CFP; acquired with a Remidio smartphone fundus camera:
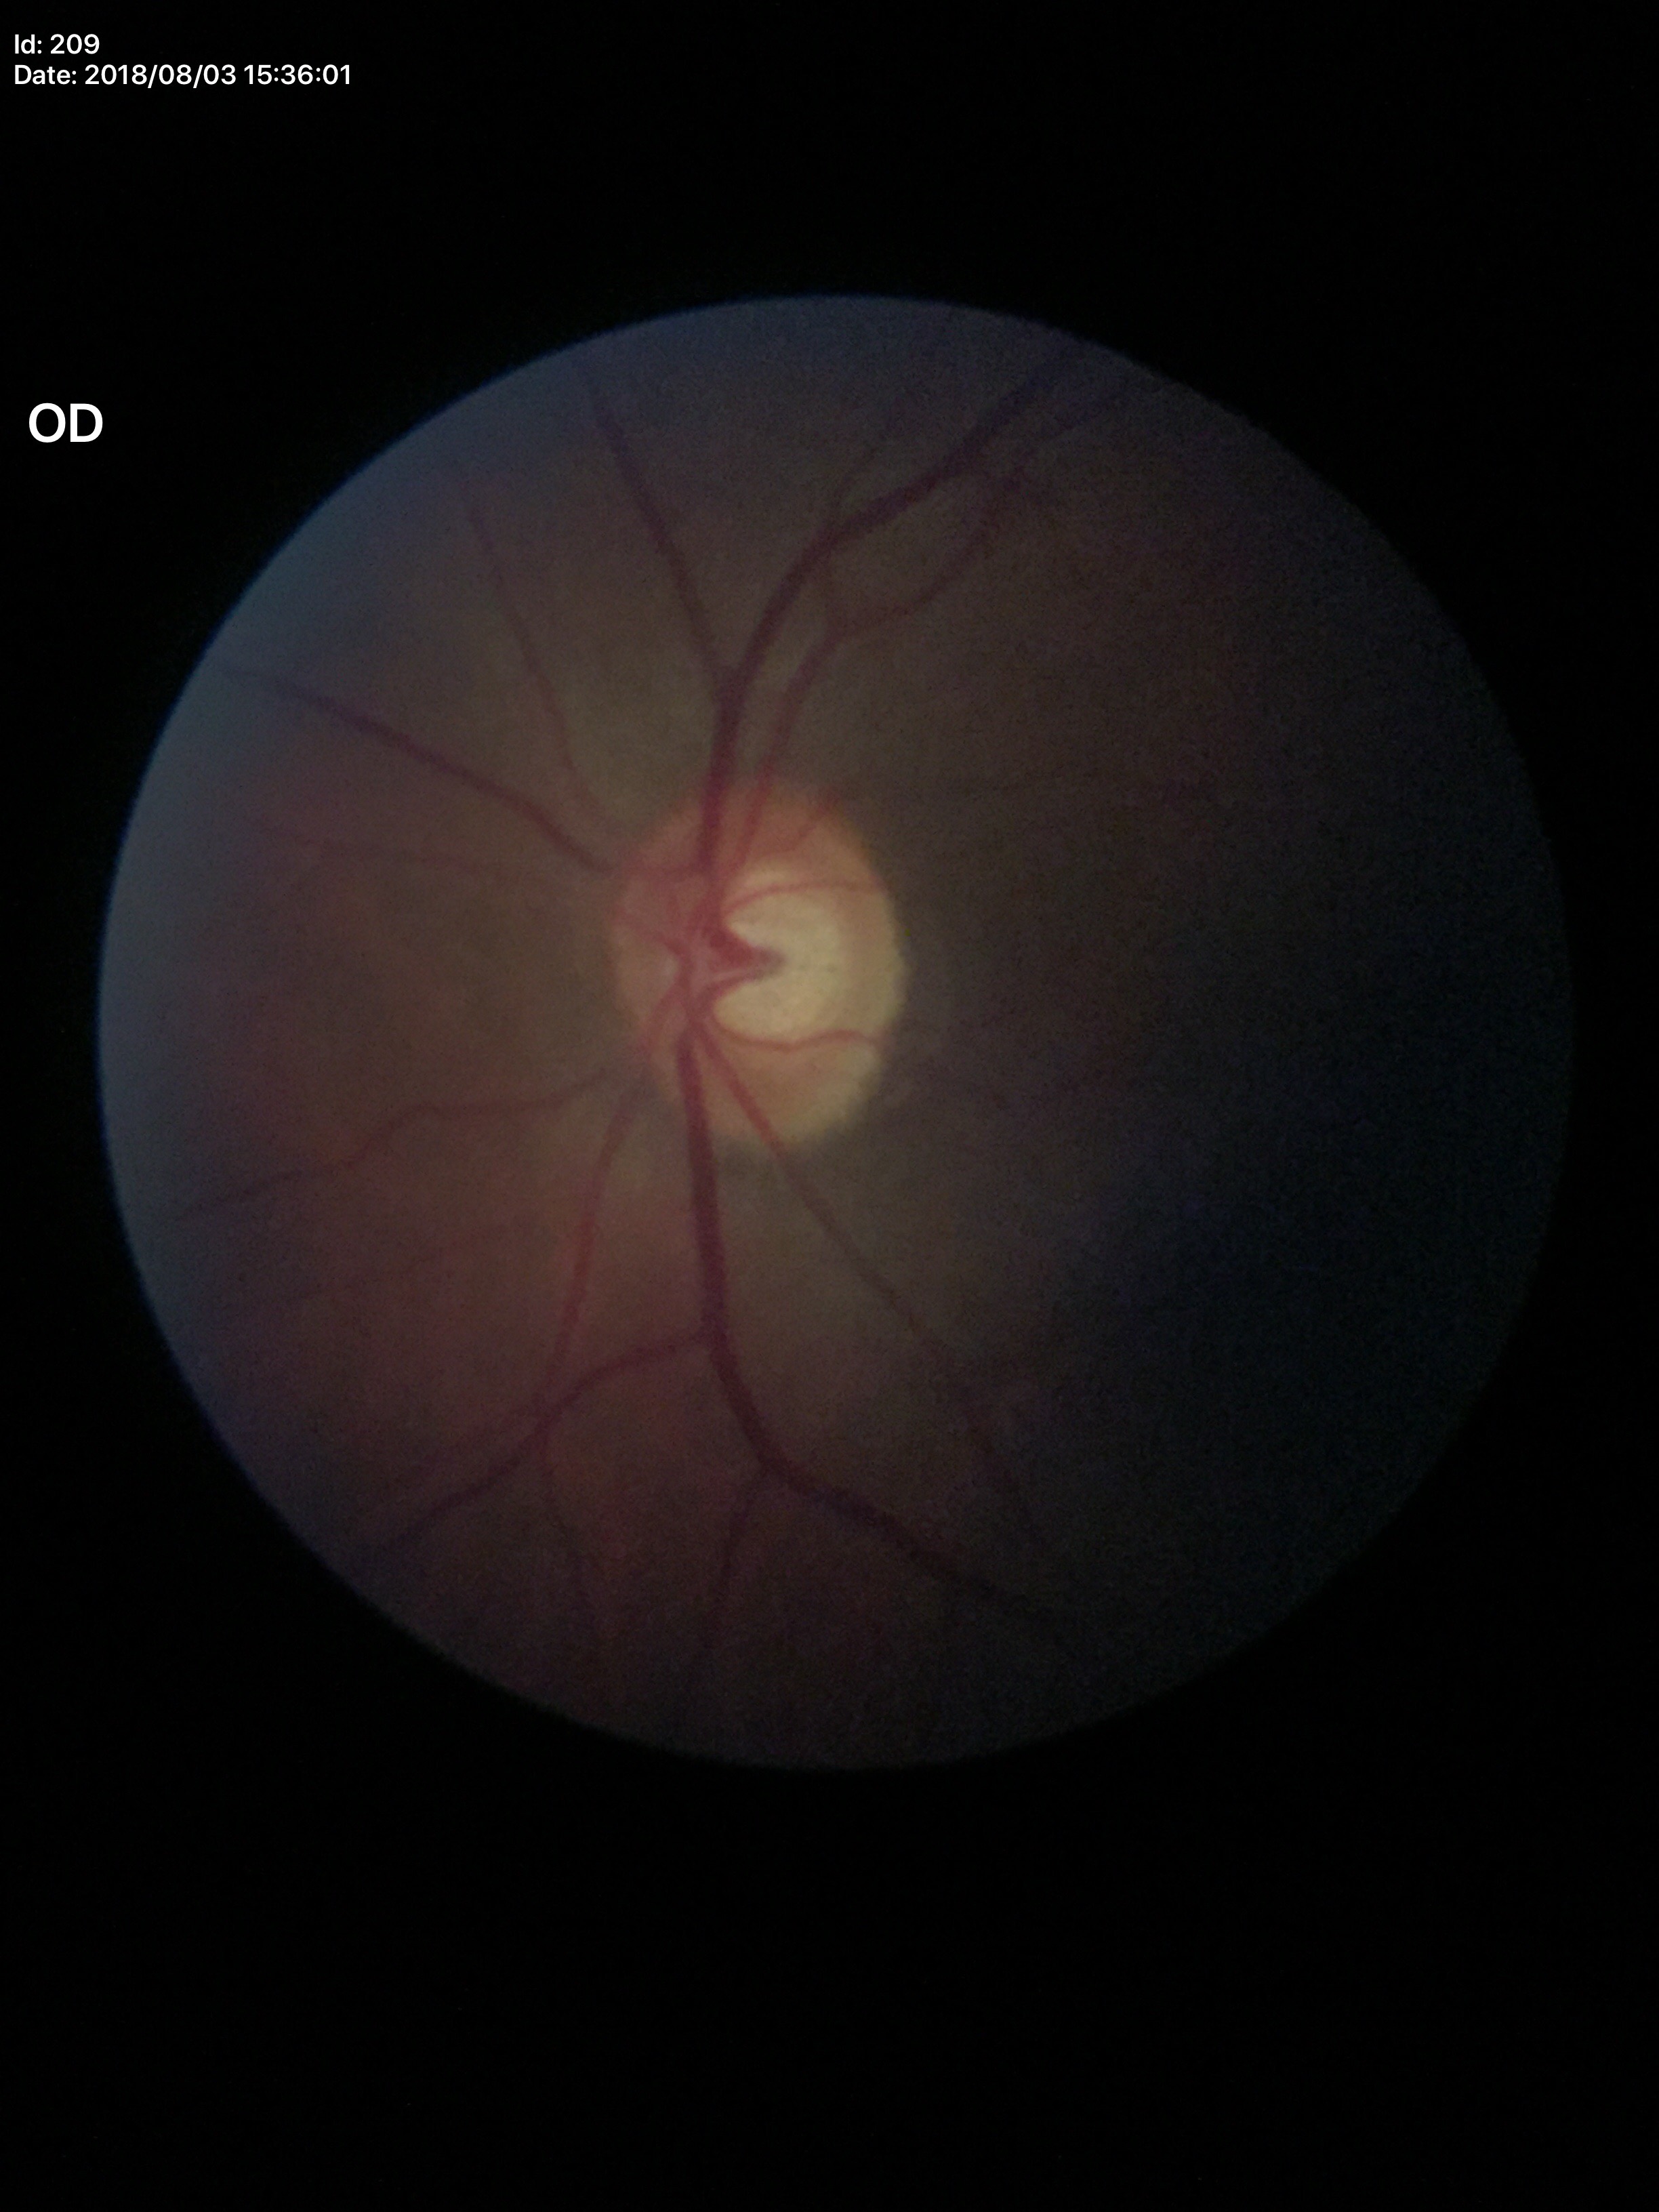
Vertical cup-disc ratio is 0.59.
Horizontal cup-disc ratio: 0.61.
Glaucoma screening impression: suspicious findings.